Modified Davis grading.
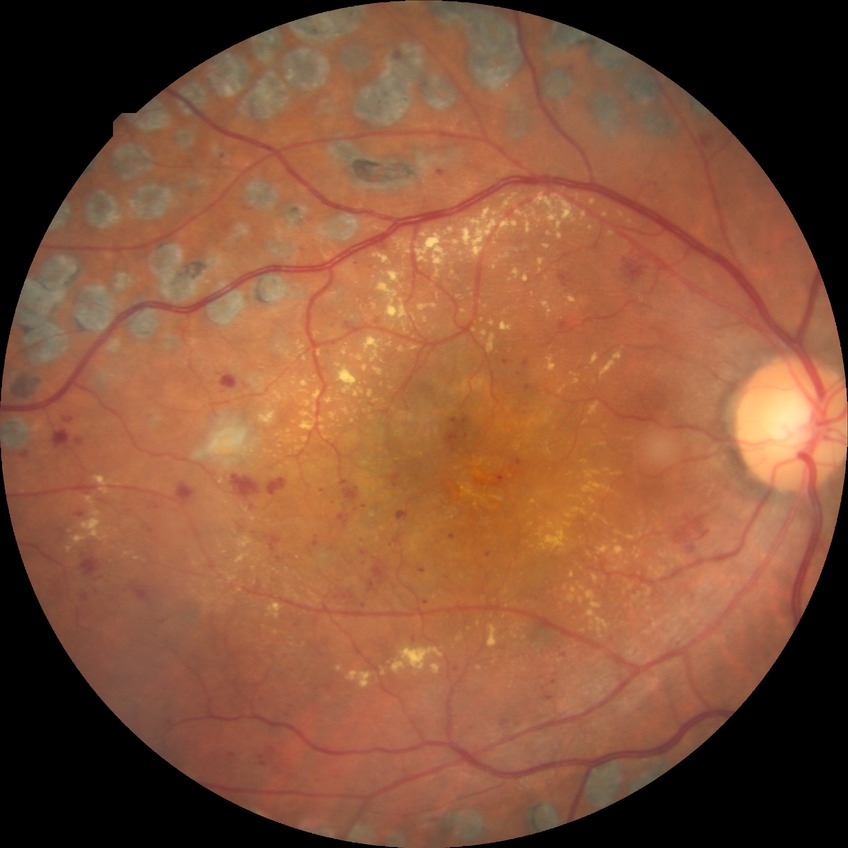 diabetic retinopathy (DR): proliferative diabetic retinopathy (PDR).